Retinal fundus photograph, image size 2346x1568, 45-degree field of view
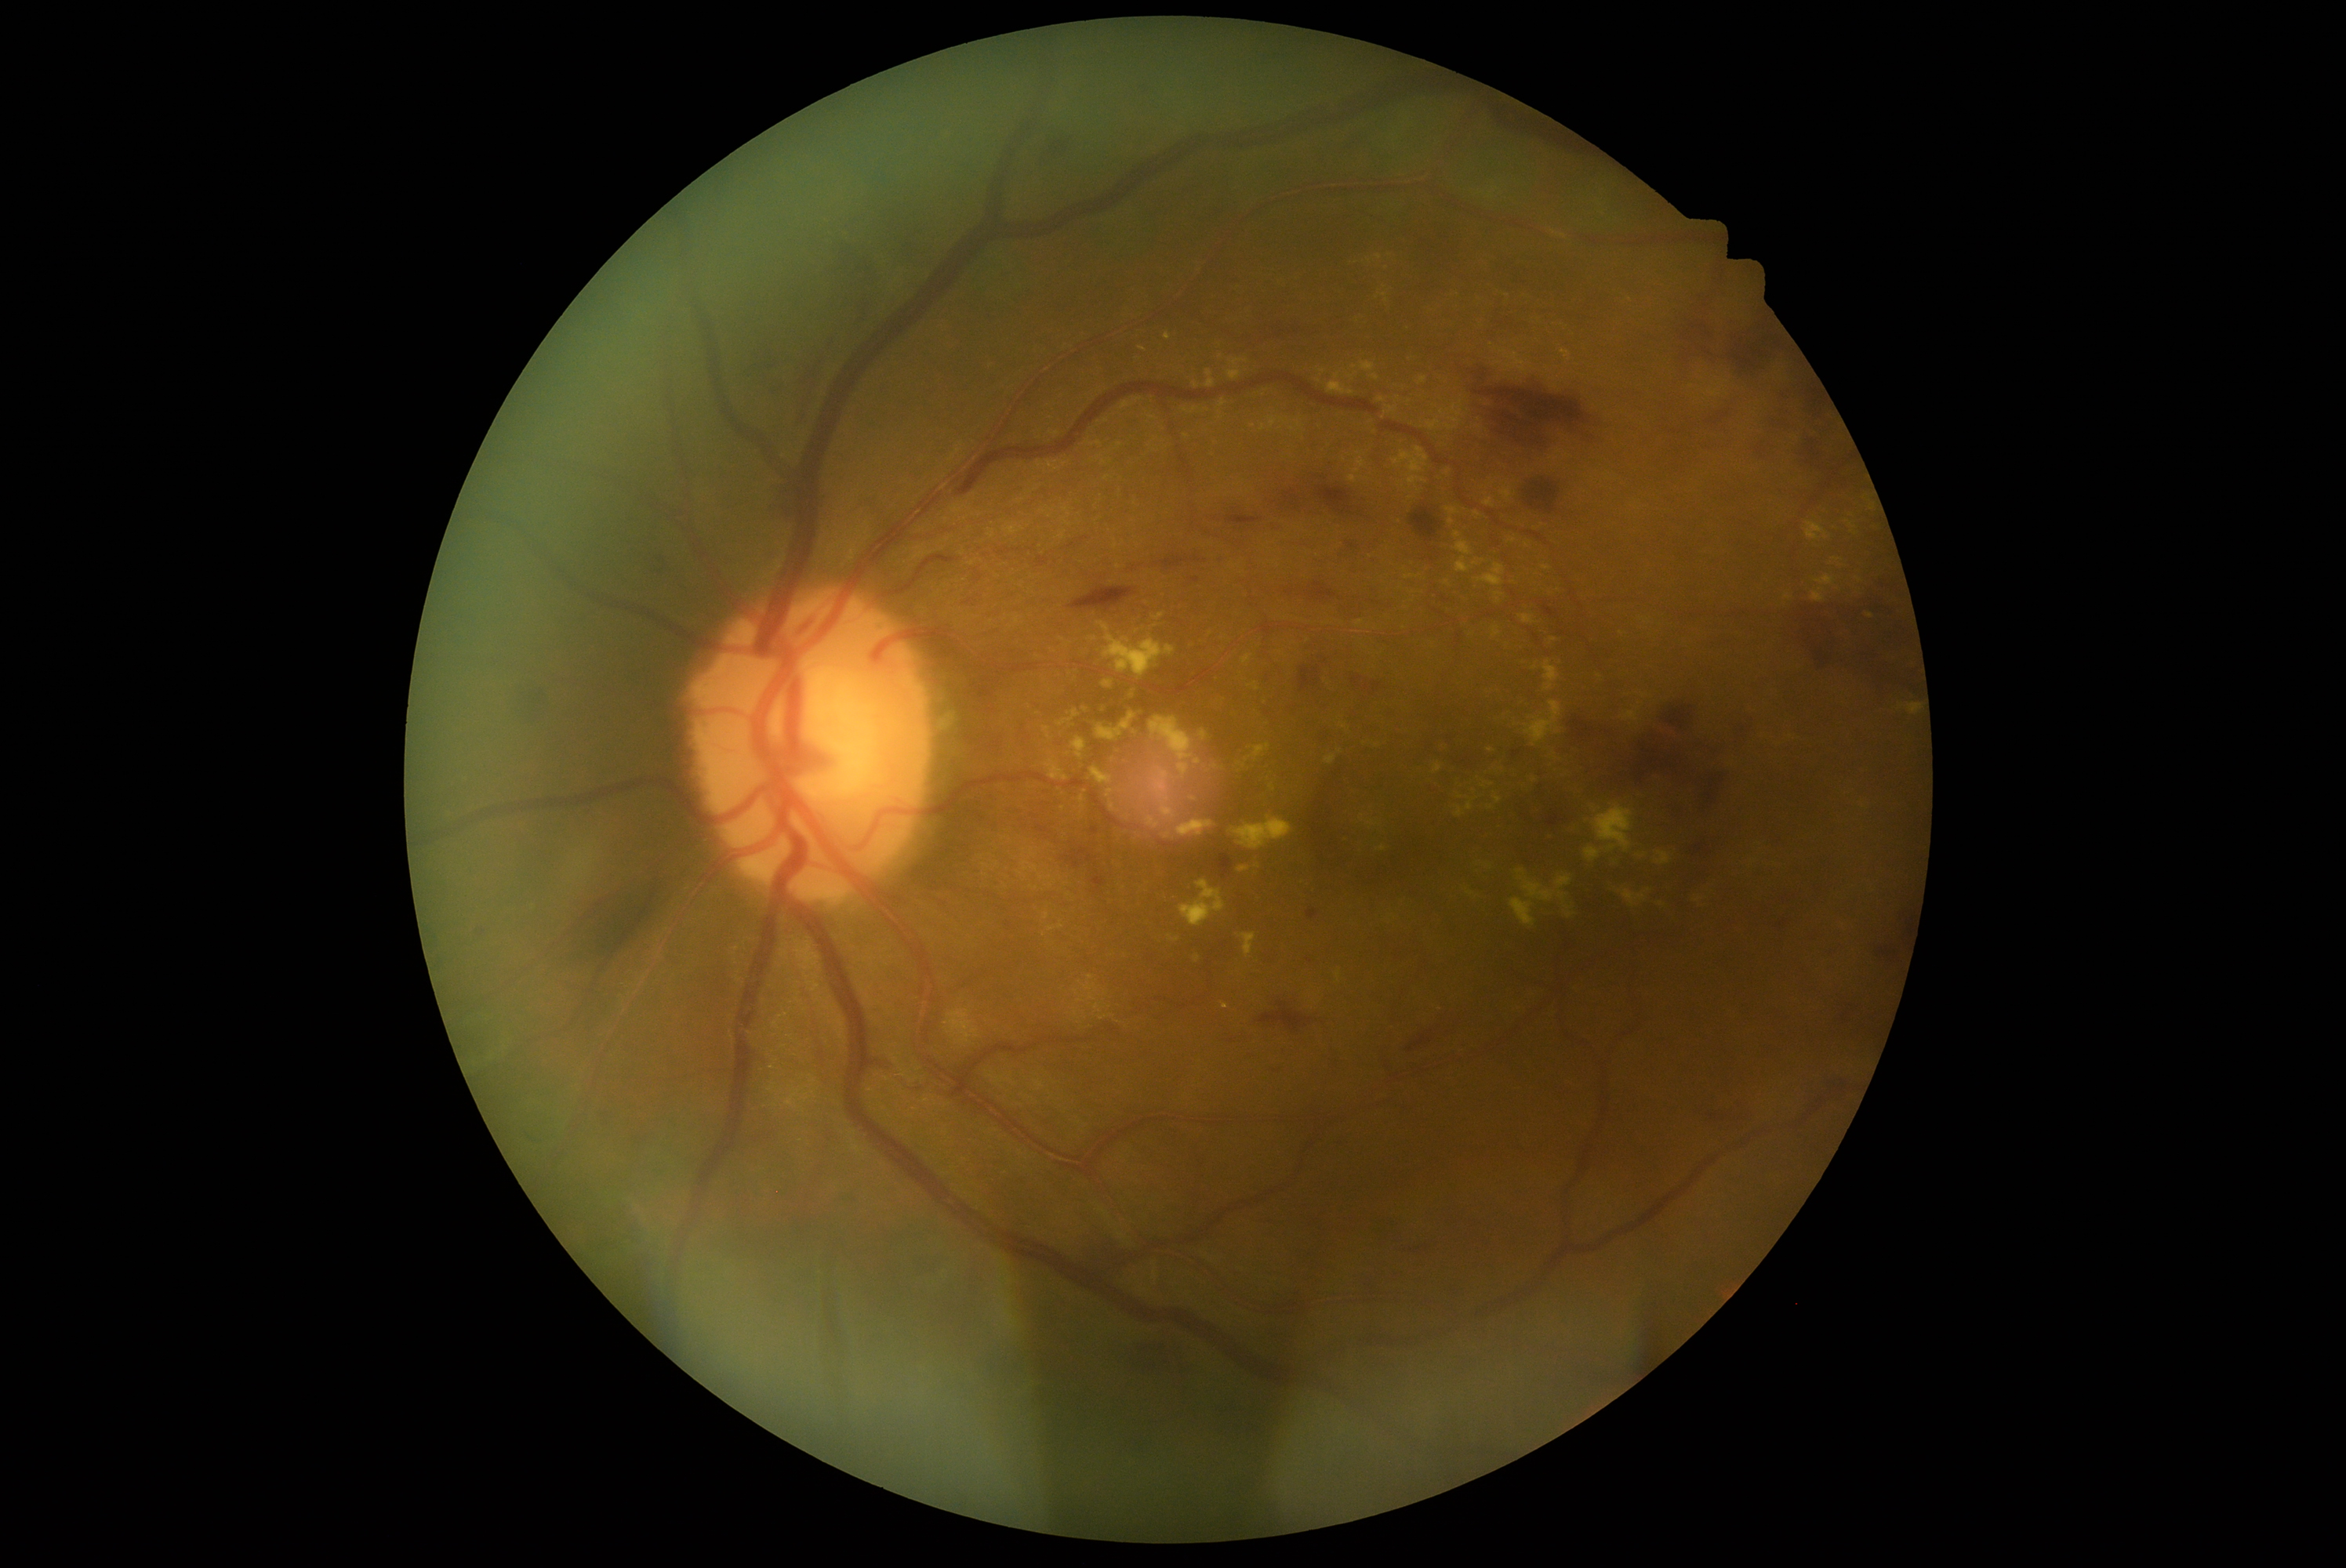 DR severity: 3.